848x848px; without pupil dilation:
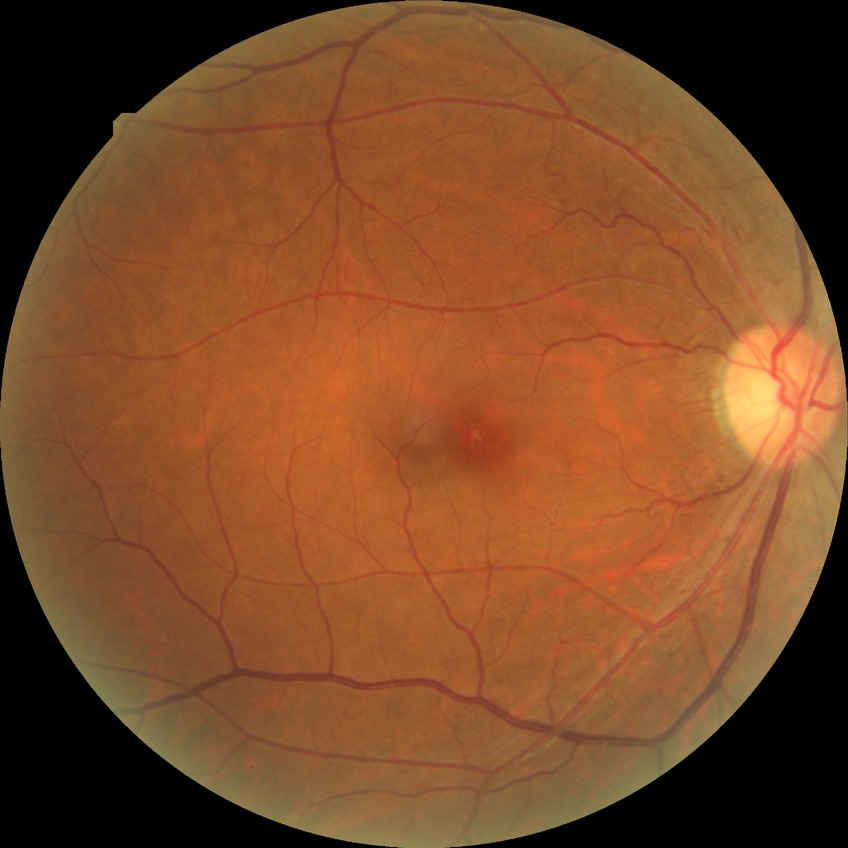 diabetic retinopathy (DR): NDR (no diabetic retinopathy).